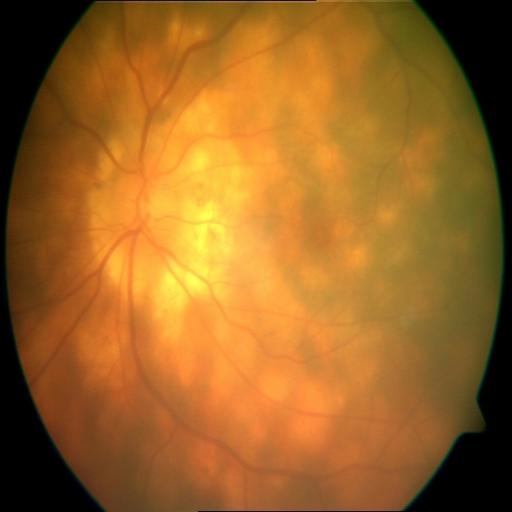
Showing chorioretinitis (CRS).